2352 x 1568 pixels. 45-degree field of view: 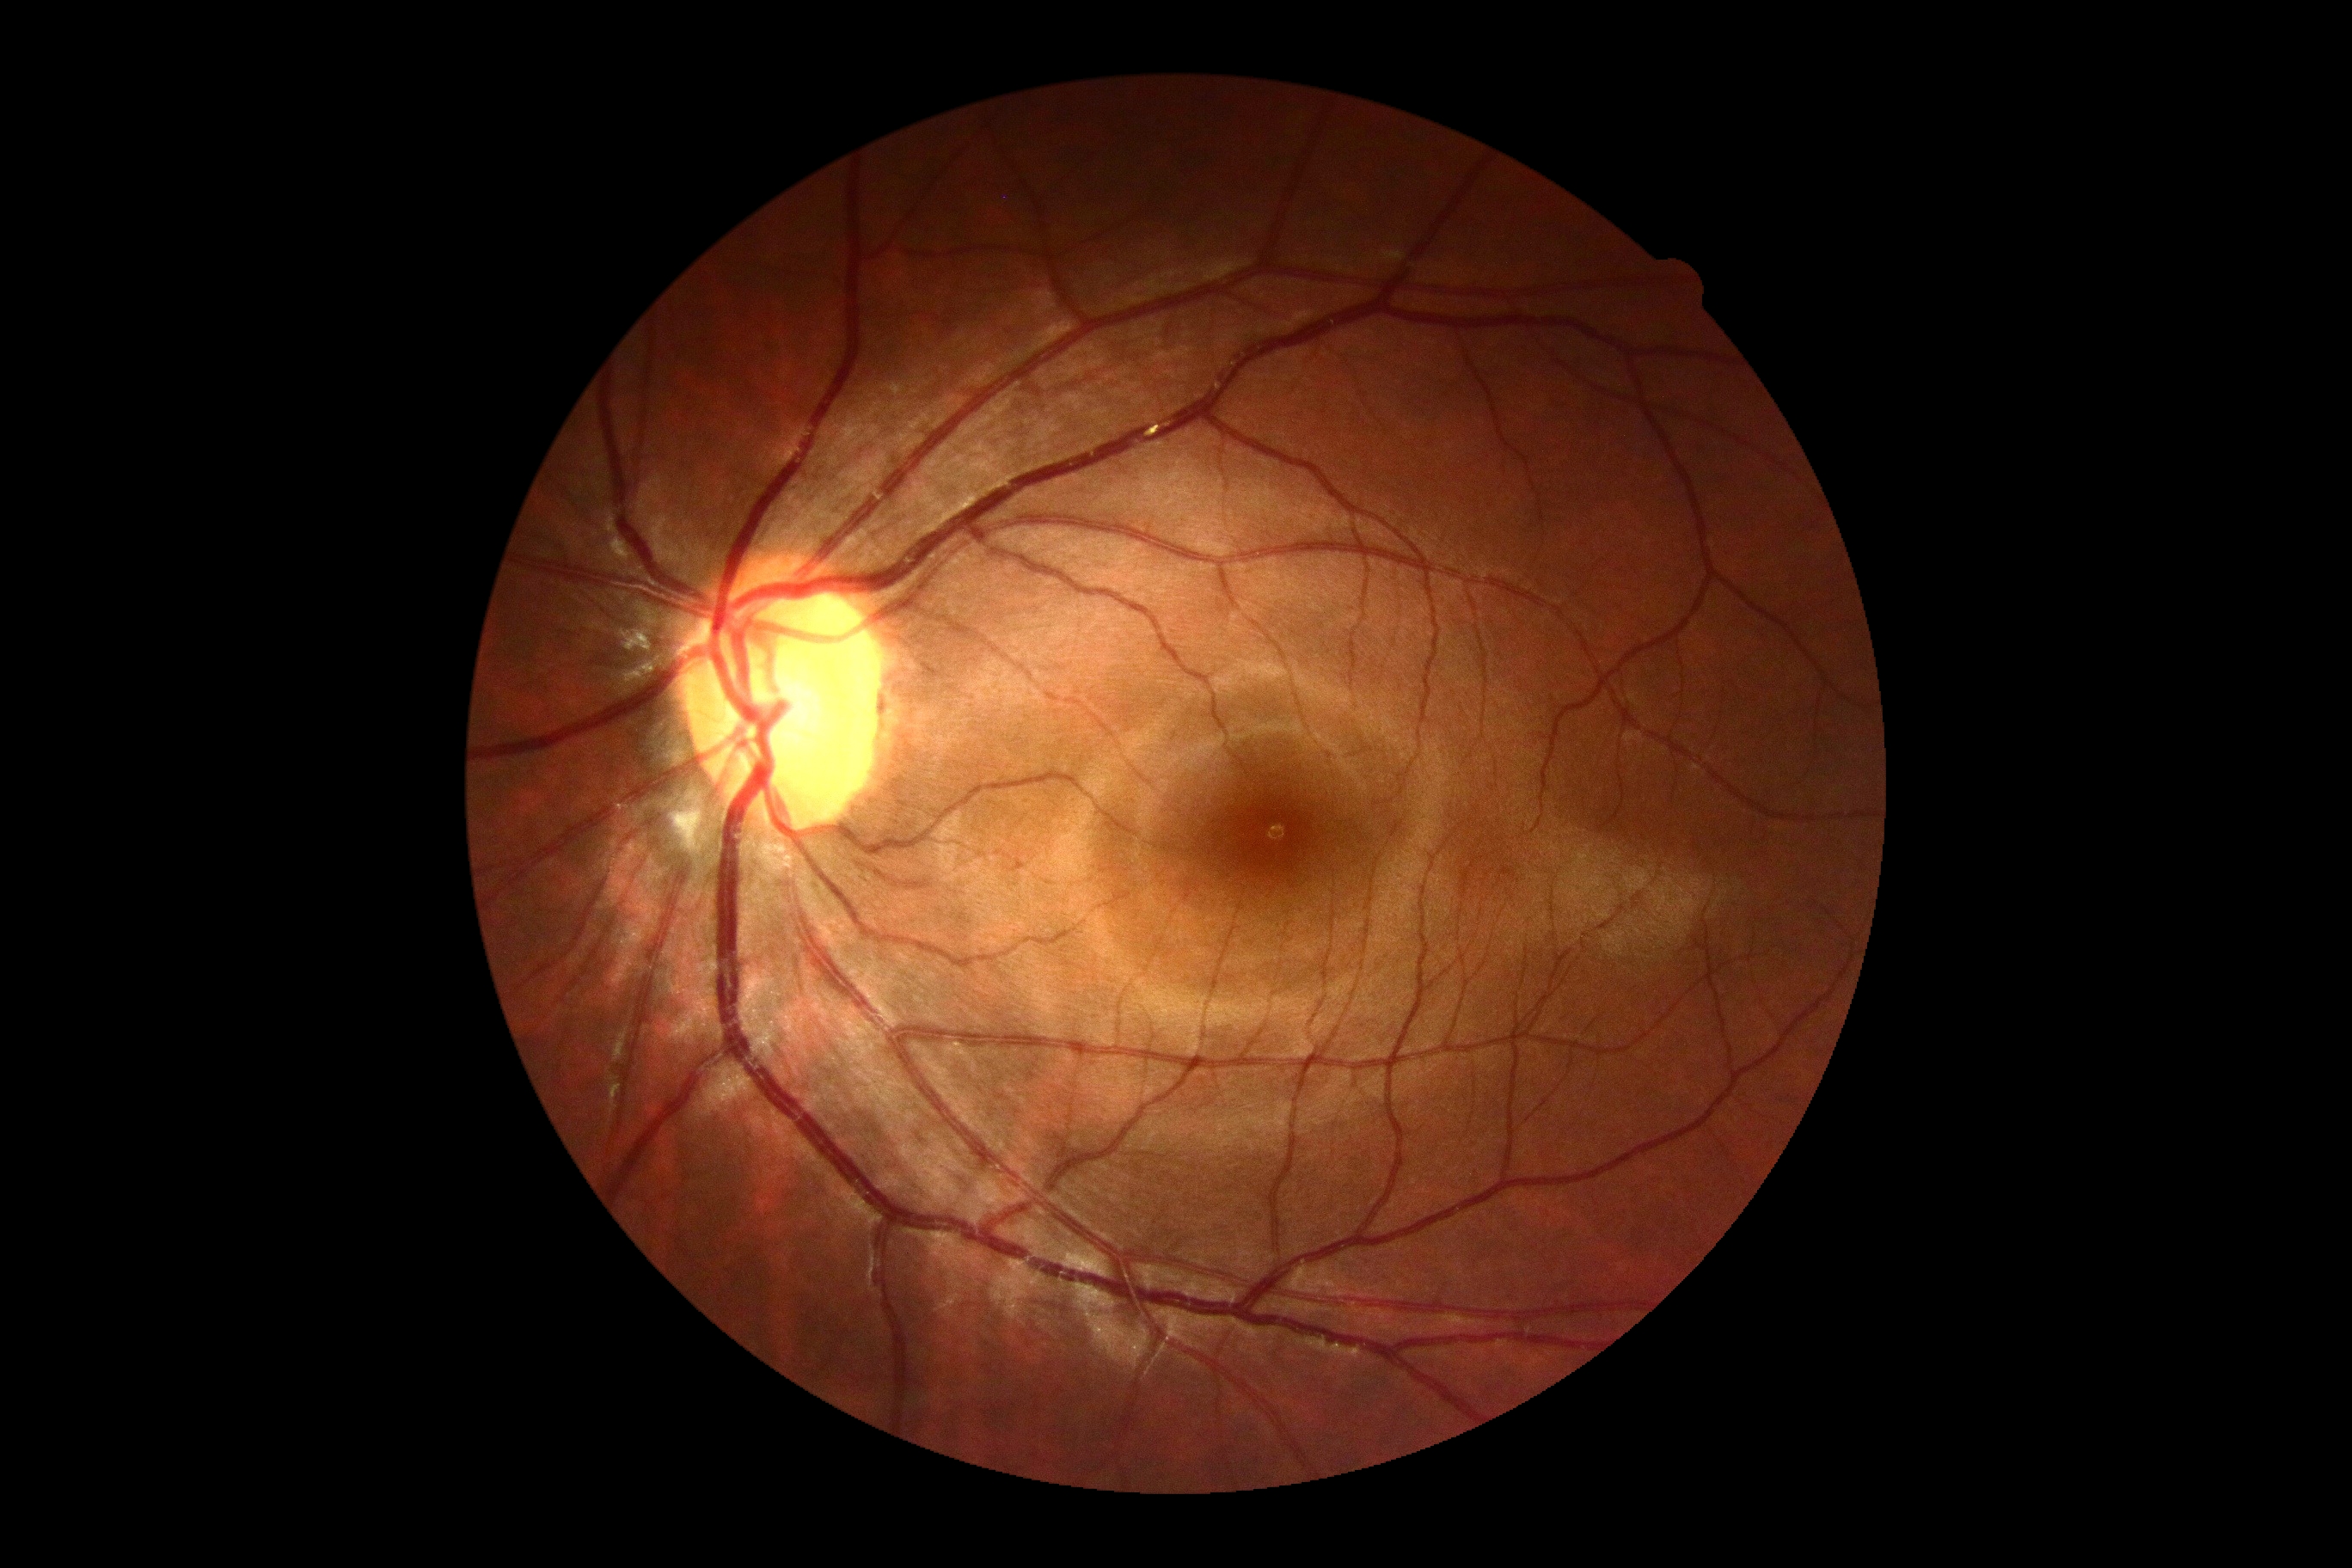 Retinopathy: 0/4.